Clarity RetCam 3, 130° FOV; pediatric retinal photograph (wide-field); image size 640x480.
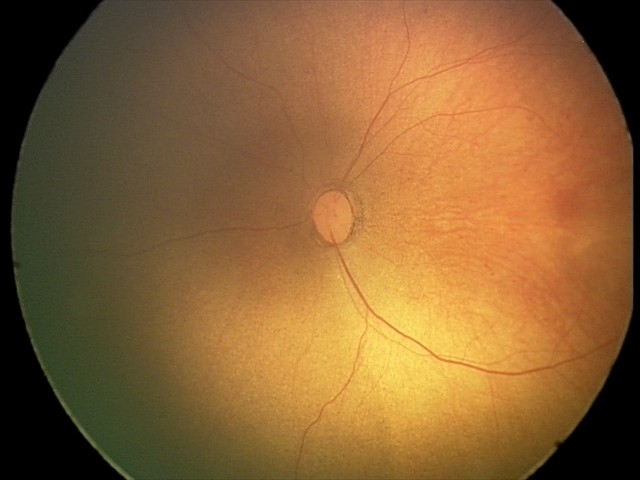

No retinal pathology identified on screening.